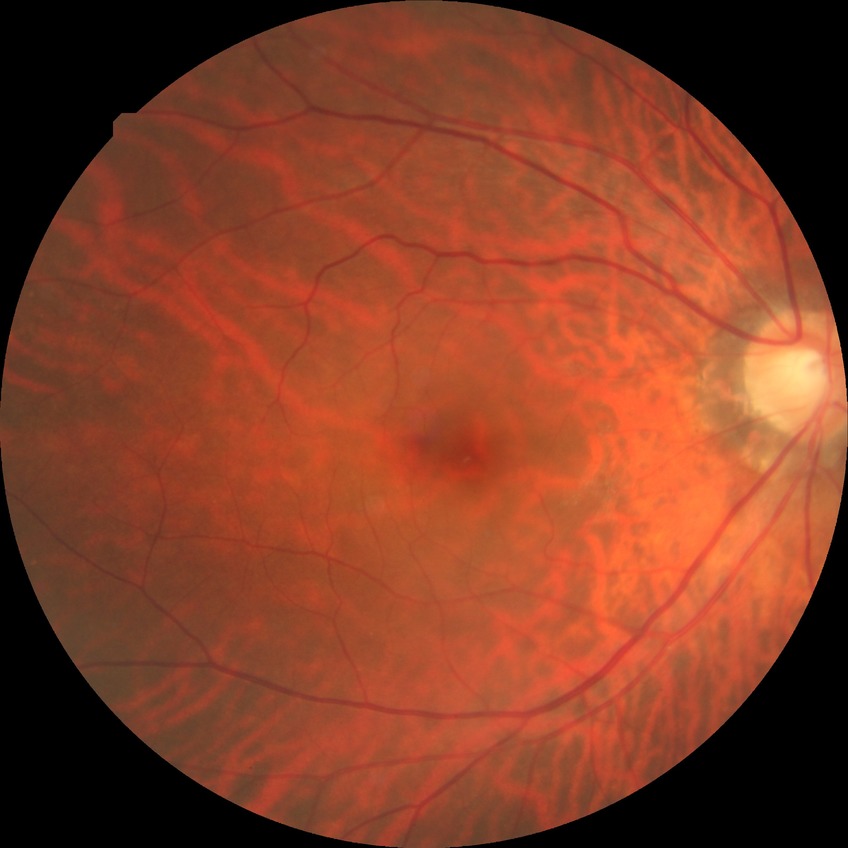

{"davis_grade": "NDR (no diabetic retinopathy)"}